NIDEK AFC-230 fundus camera. Nonmydriatic. Davis DR grading. 45 degree fundus photograph: 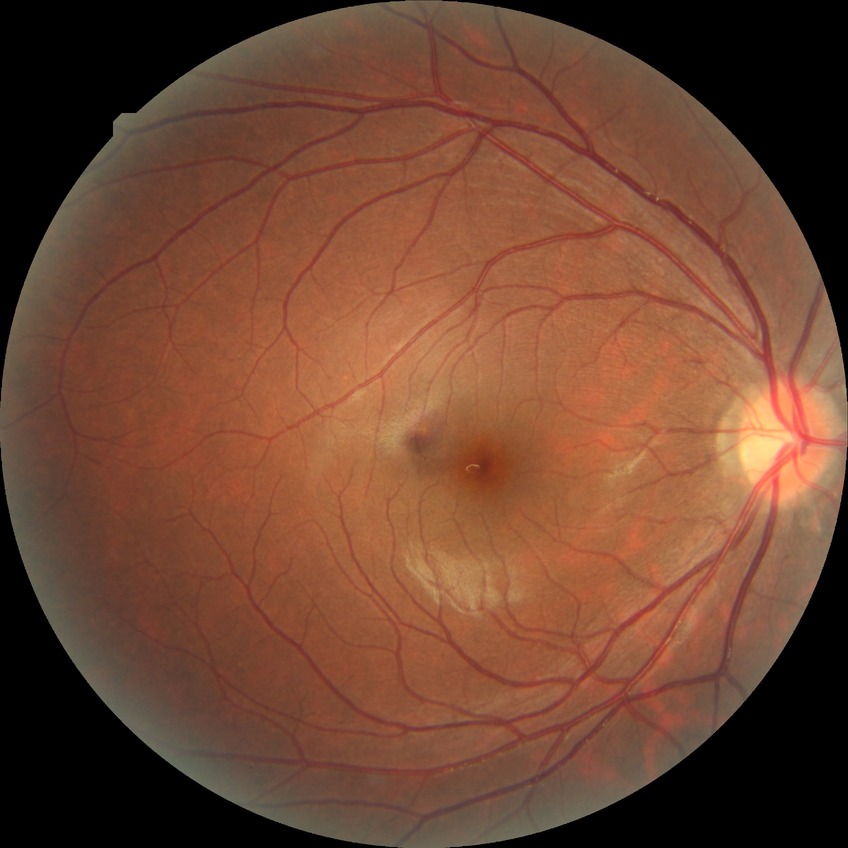 No signs of diabetic retinopathy.
Modified Davis grade: NDR.